848x848px. Modified Davis classification.
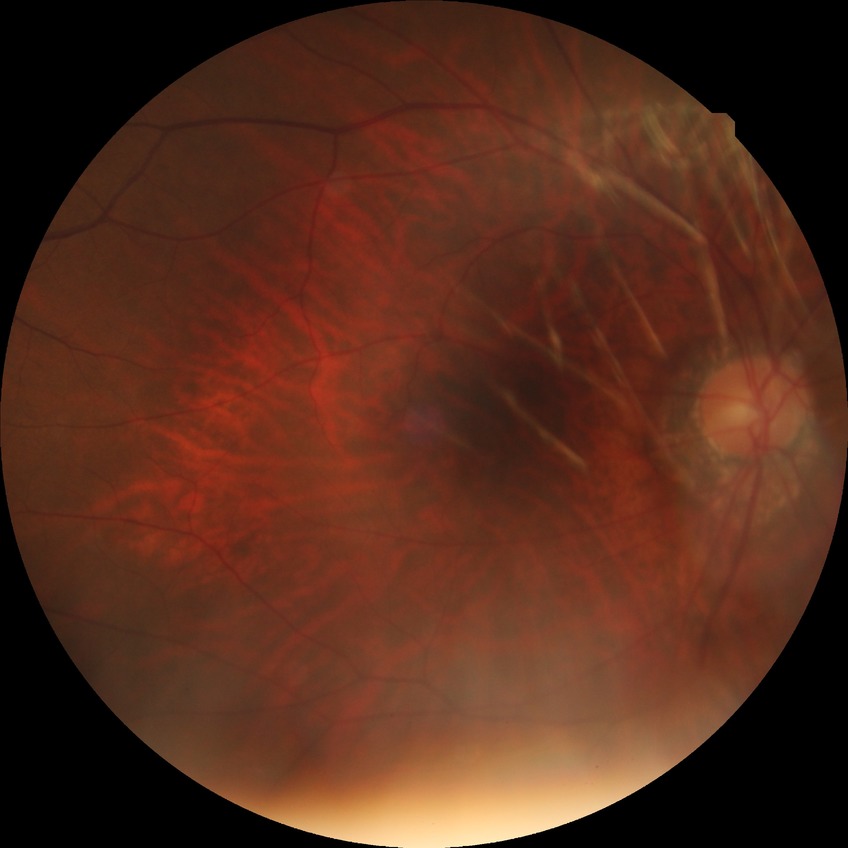

retinopathy grade: no diabetic retinopathy.